45° FOV · color fundus photograph
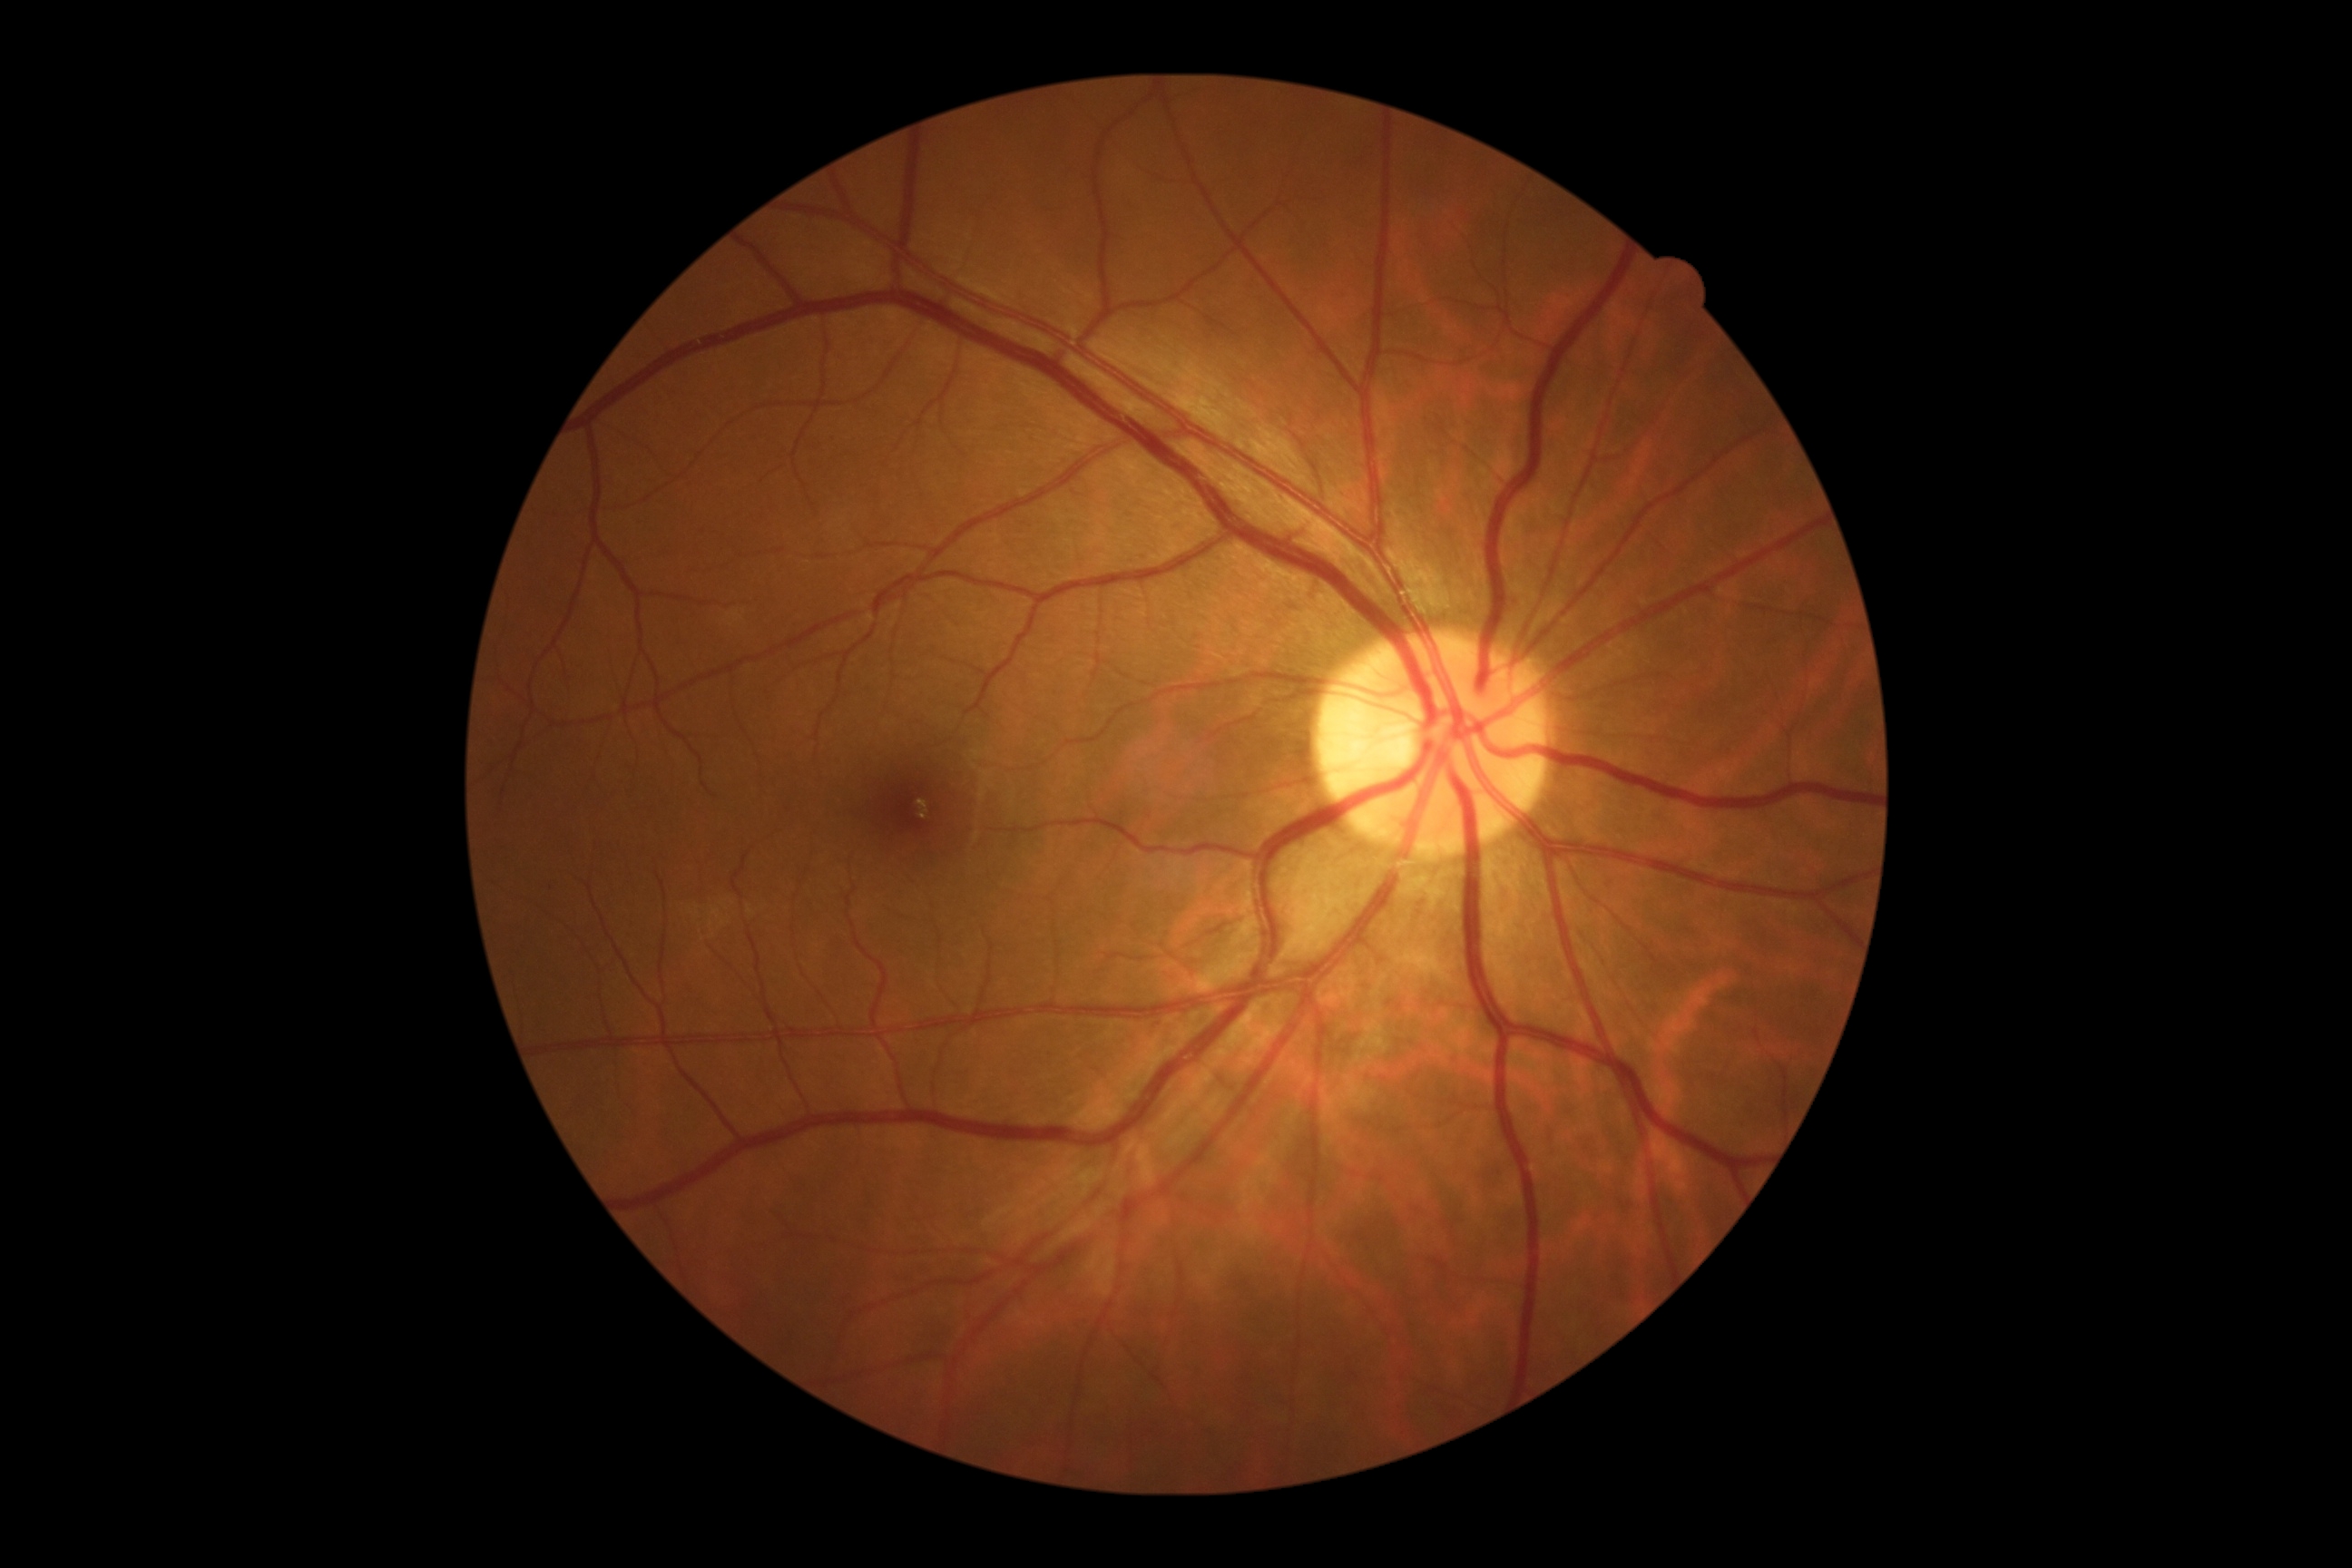

DR: grade 0 | DR impression: negative for DR.